NIDEK AFC-230 fundus camera
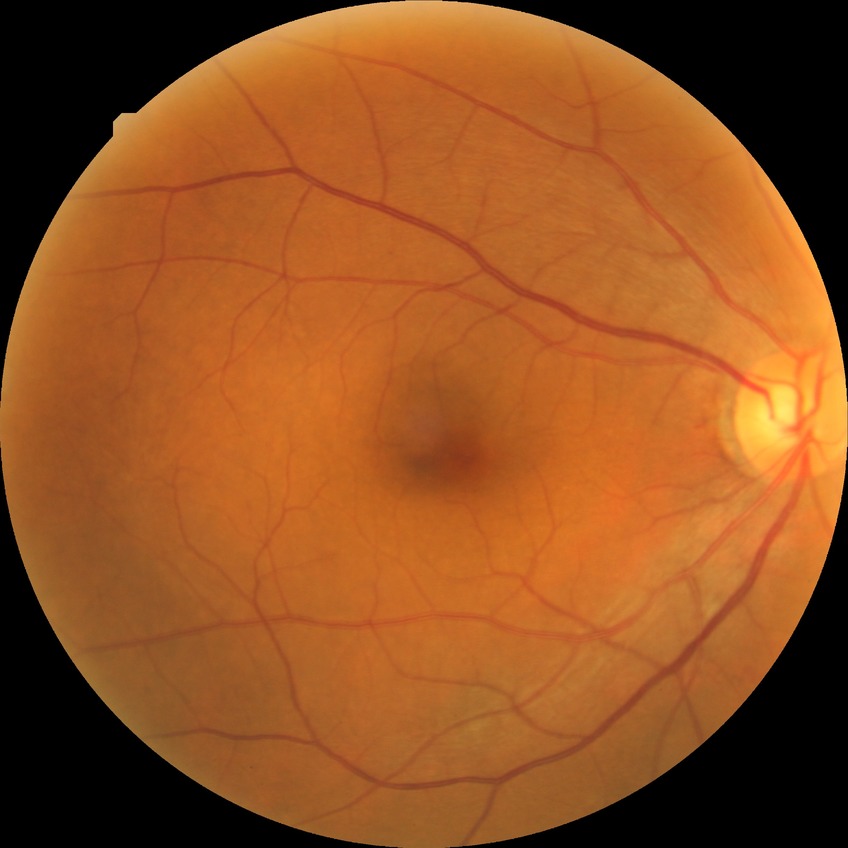
Findings:
• diabetic retinopathy (DR) — NDR (no diabetic retinopathy)